Wide-field contact fundus photograph of an infant. Captured with the Phoenix ICON (100° field of view)
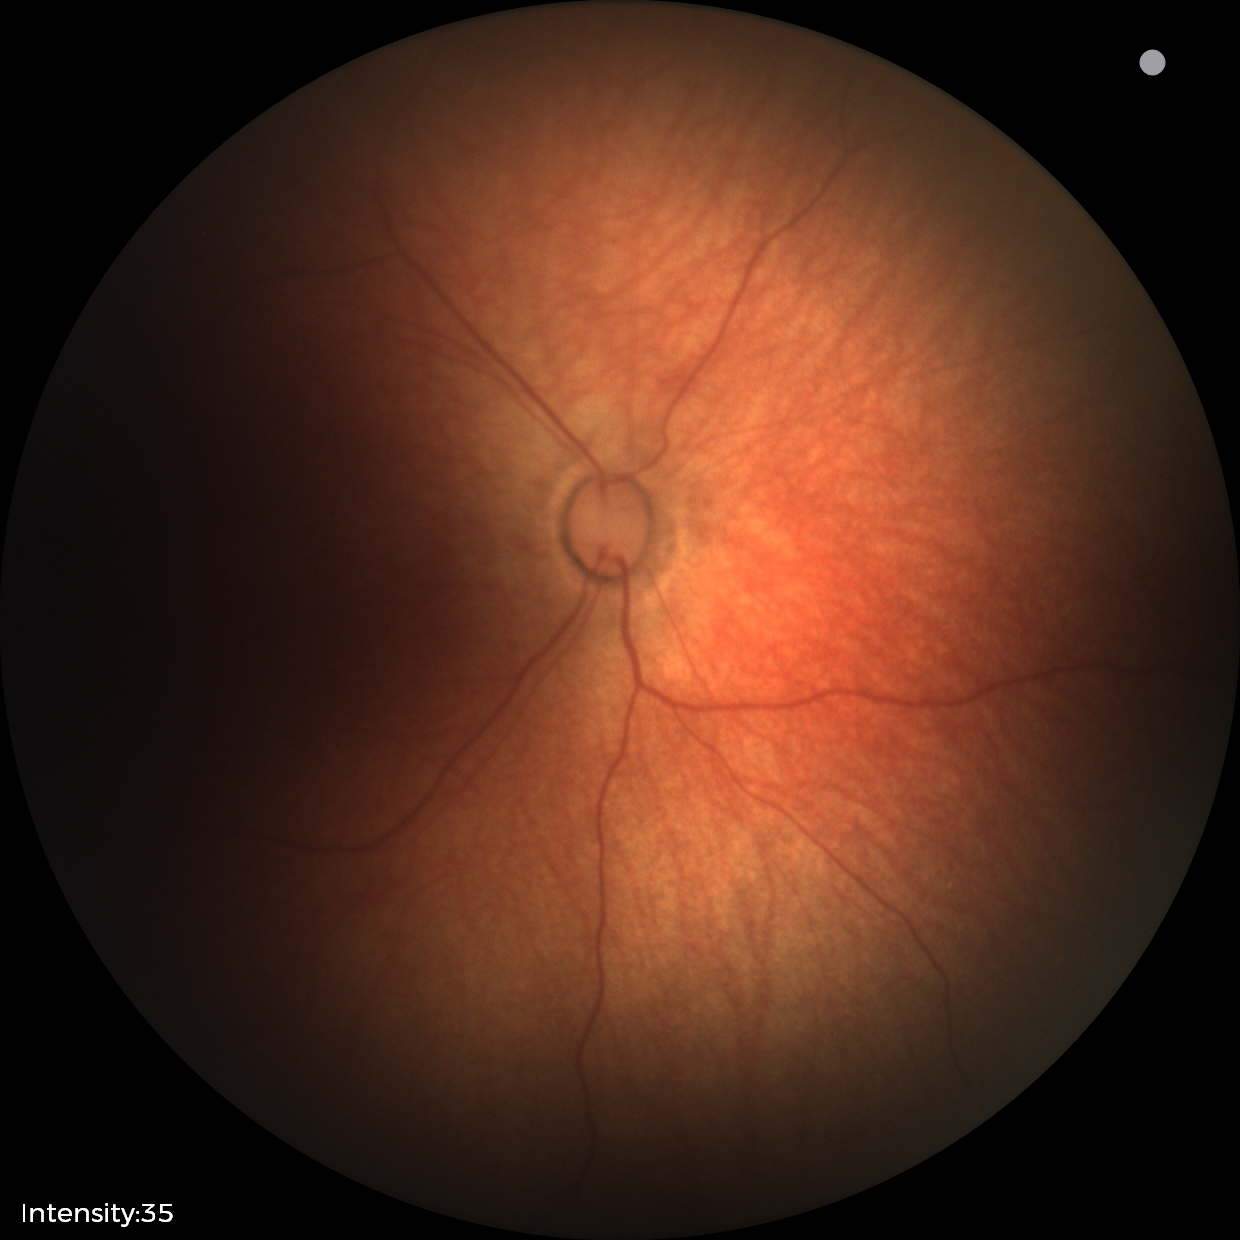

Assessment: normal retinal appearance.